45-degree field of view — 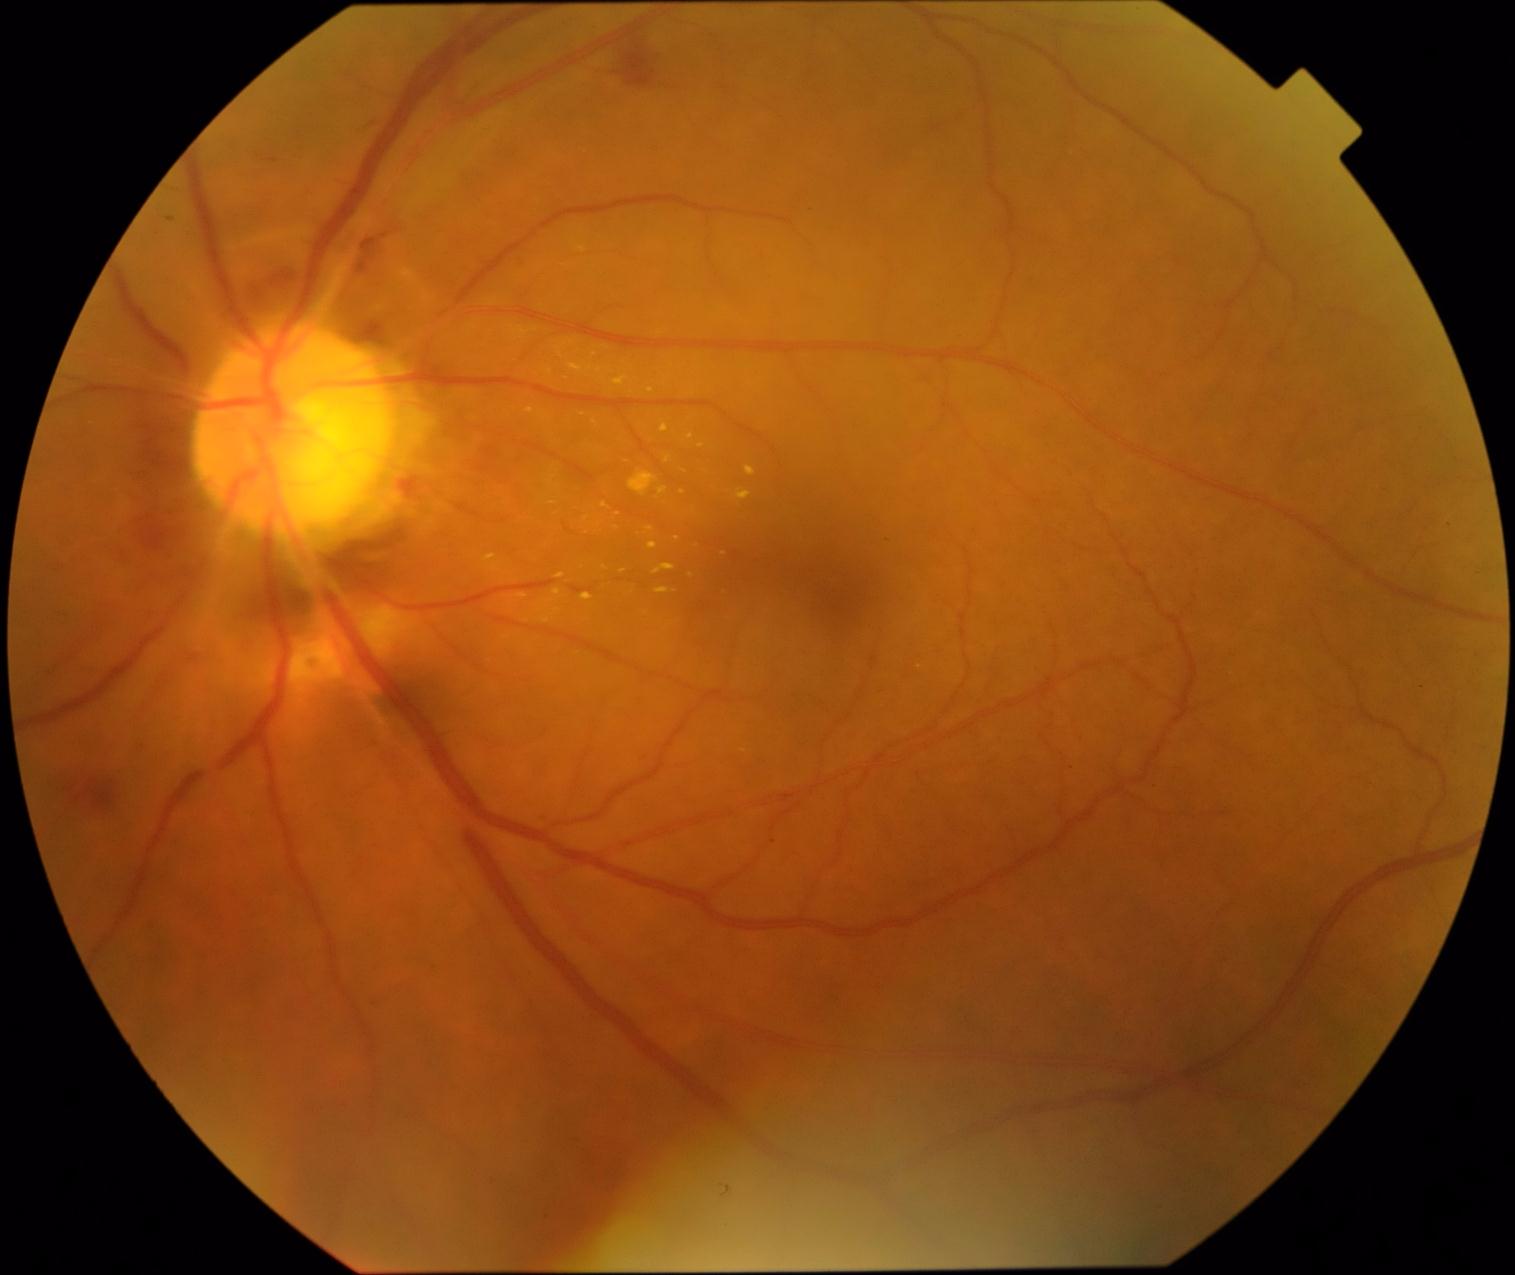
* DR class — non-proliferative diabetic retinopathy
* retinopathy — 2 — more than just microaneurysms but less than severe NPDR